Color fundus photograph. DR severity per modified Davis staging.
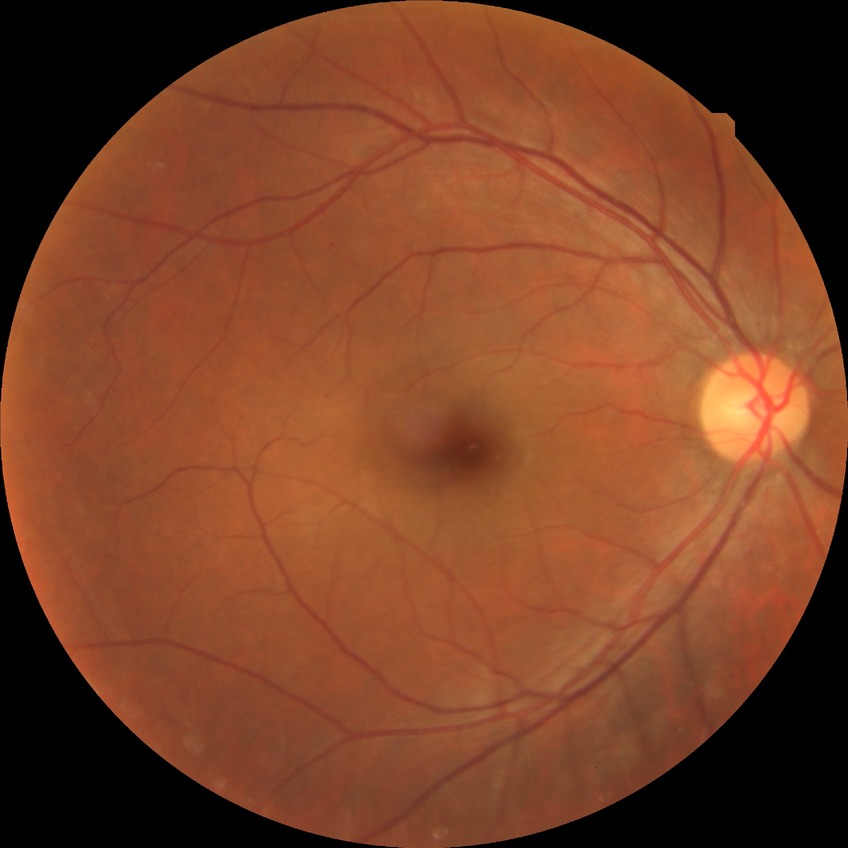

Diabetic retinopathy stage is simple diabetic retinopathy.